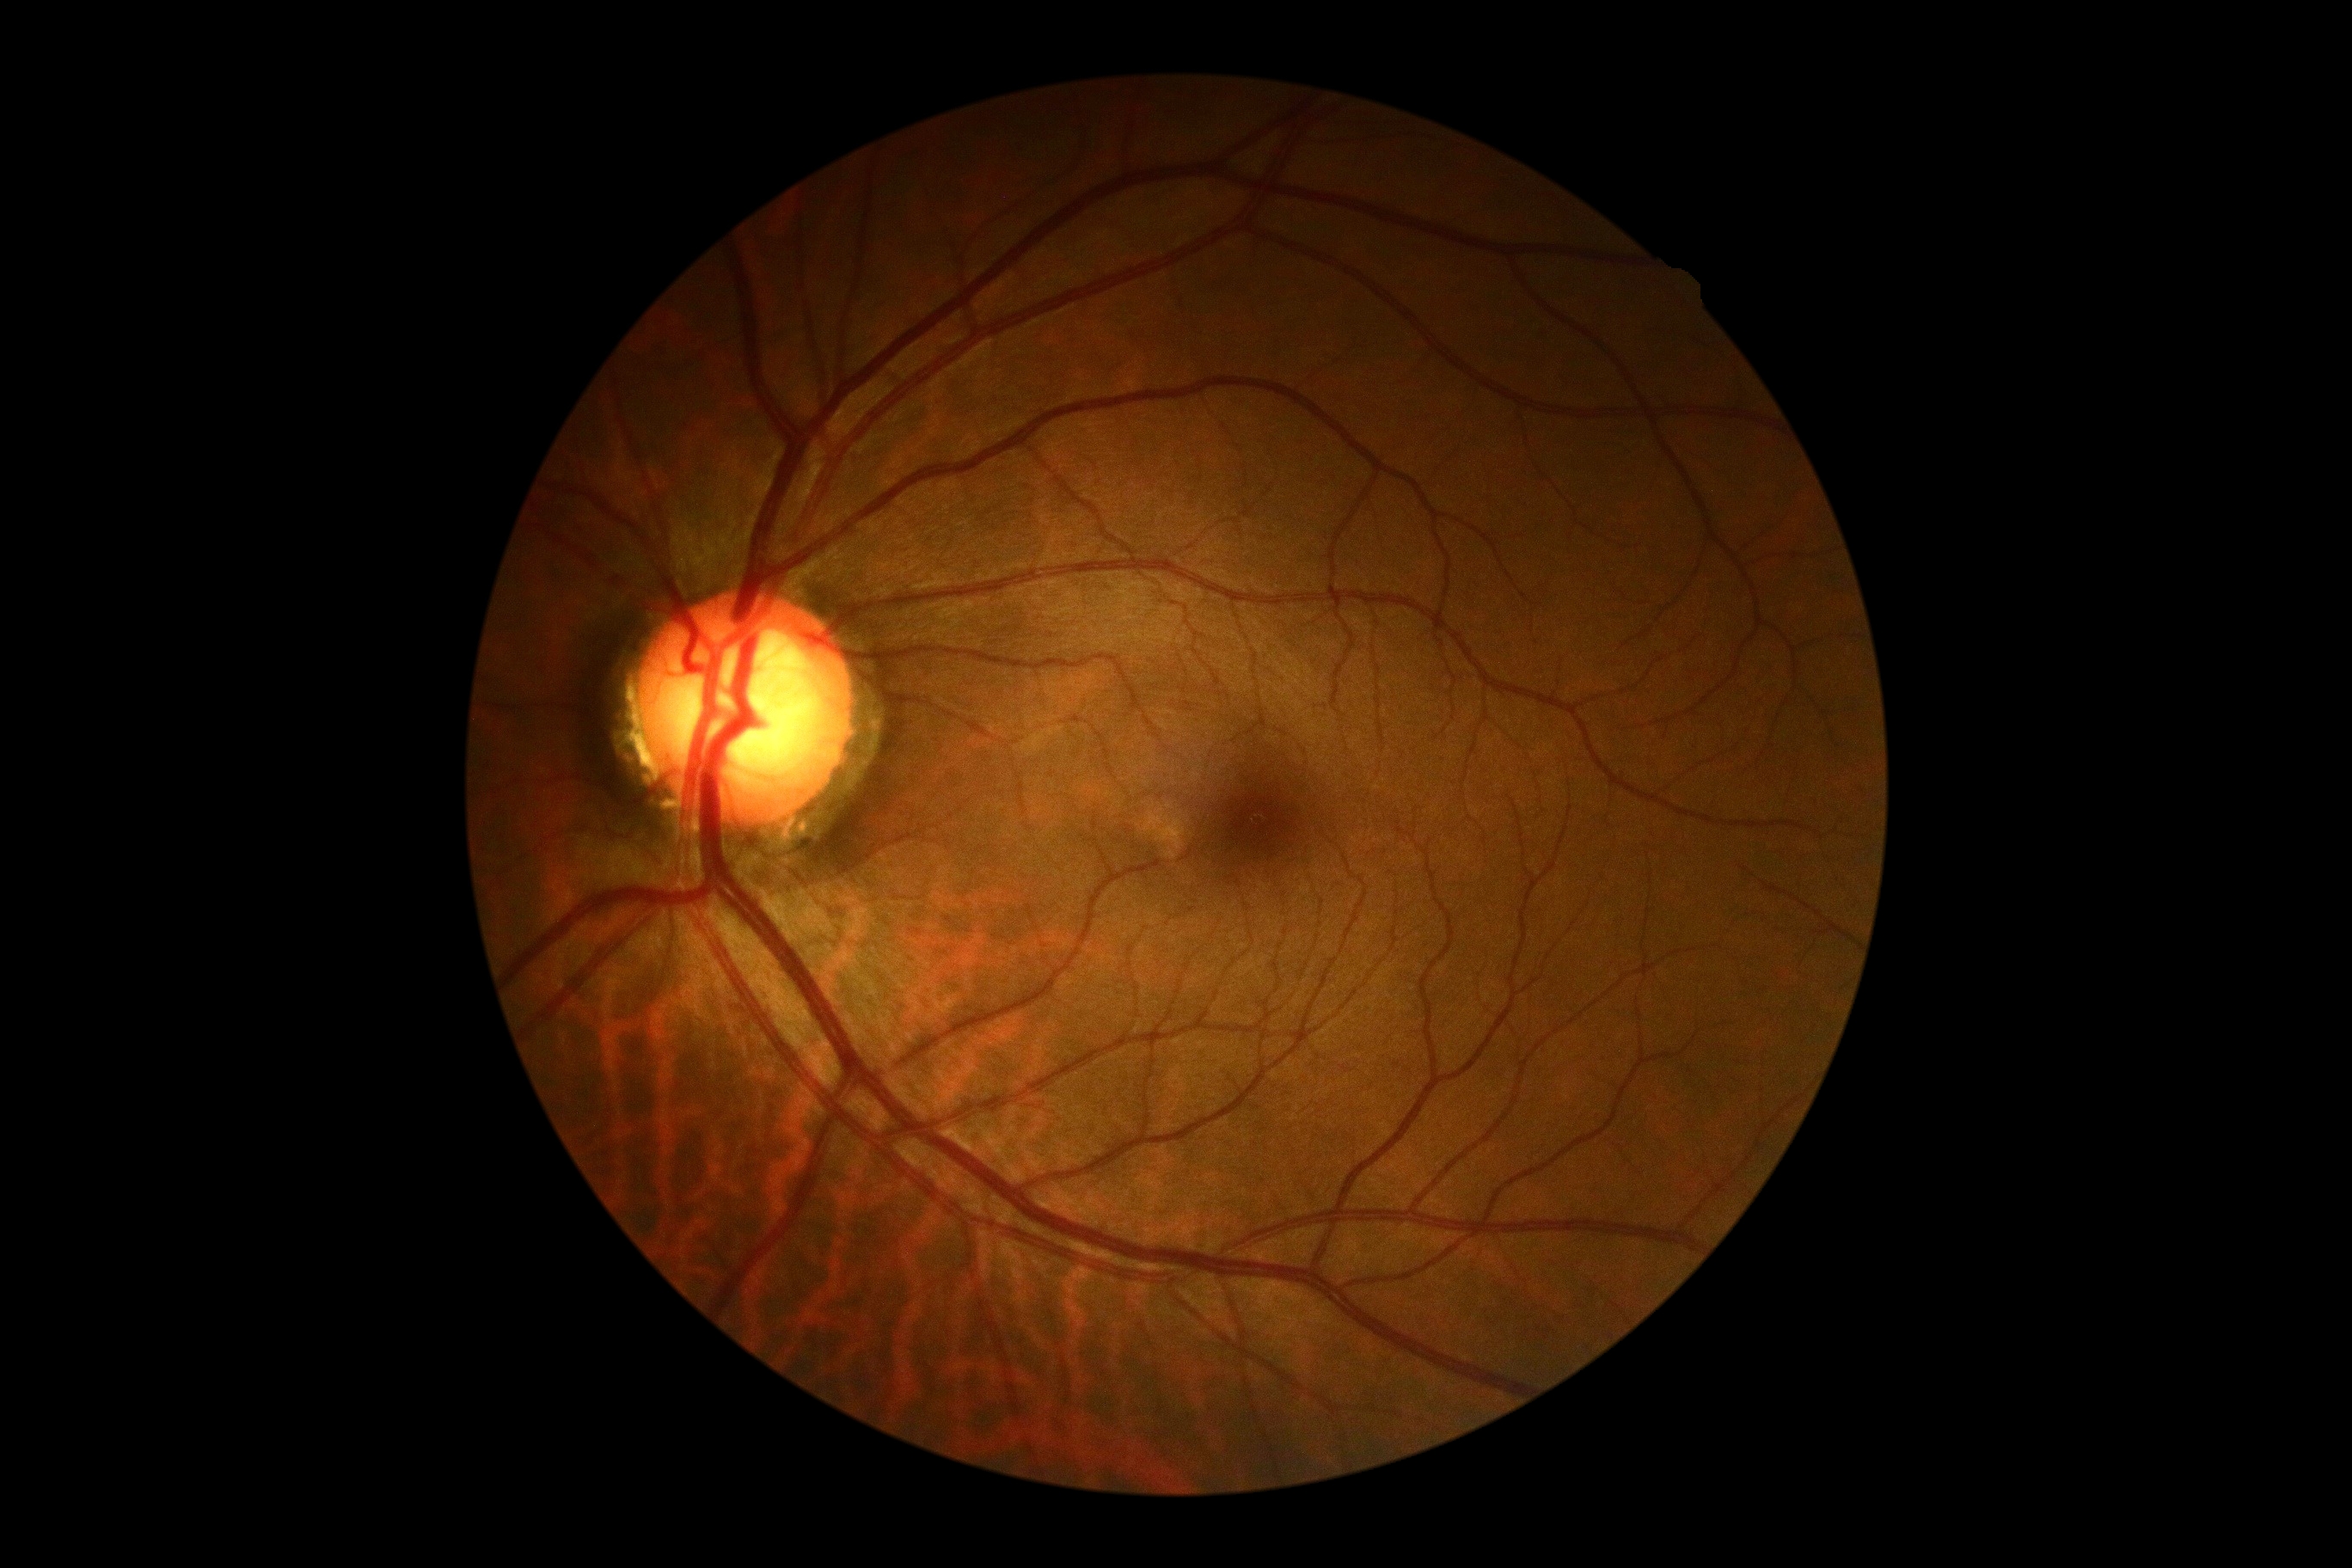 DR impression: negative for DR; DR stage: no apparent diabetic retinopathy (grade 0).